Mydriatic (tropicamide and phenylephrine), 2228x1652, 50° FOV, retinal fundus photograph, posterior pole field covering the optic disc and macula, Topcon TRC-50DX — 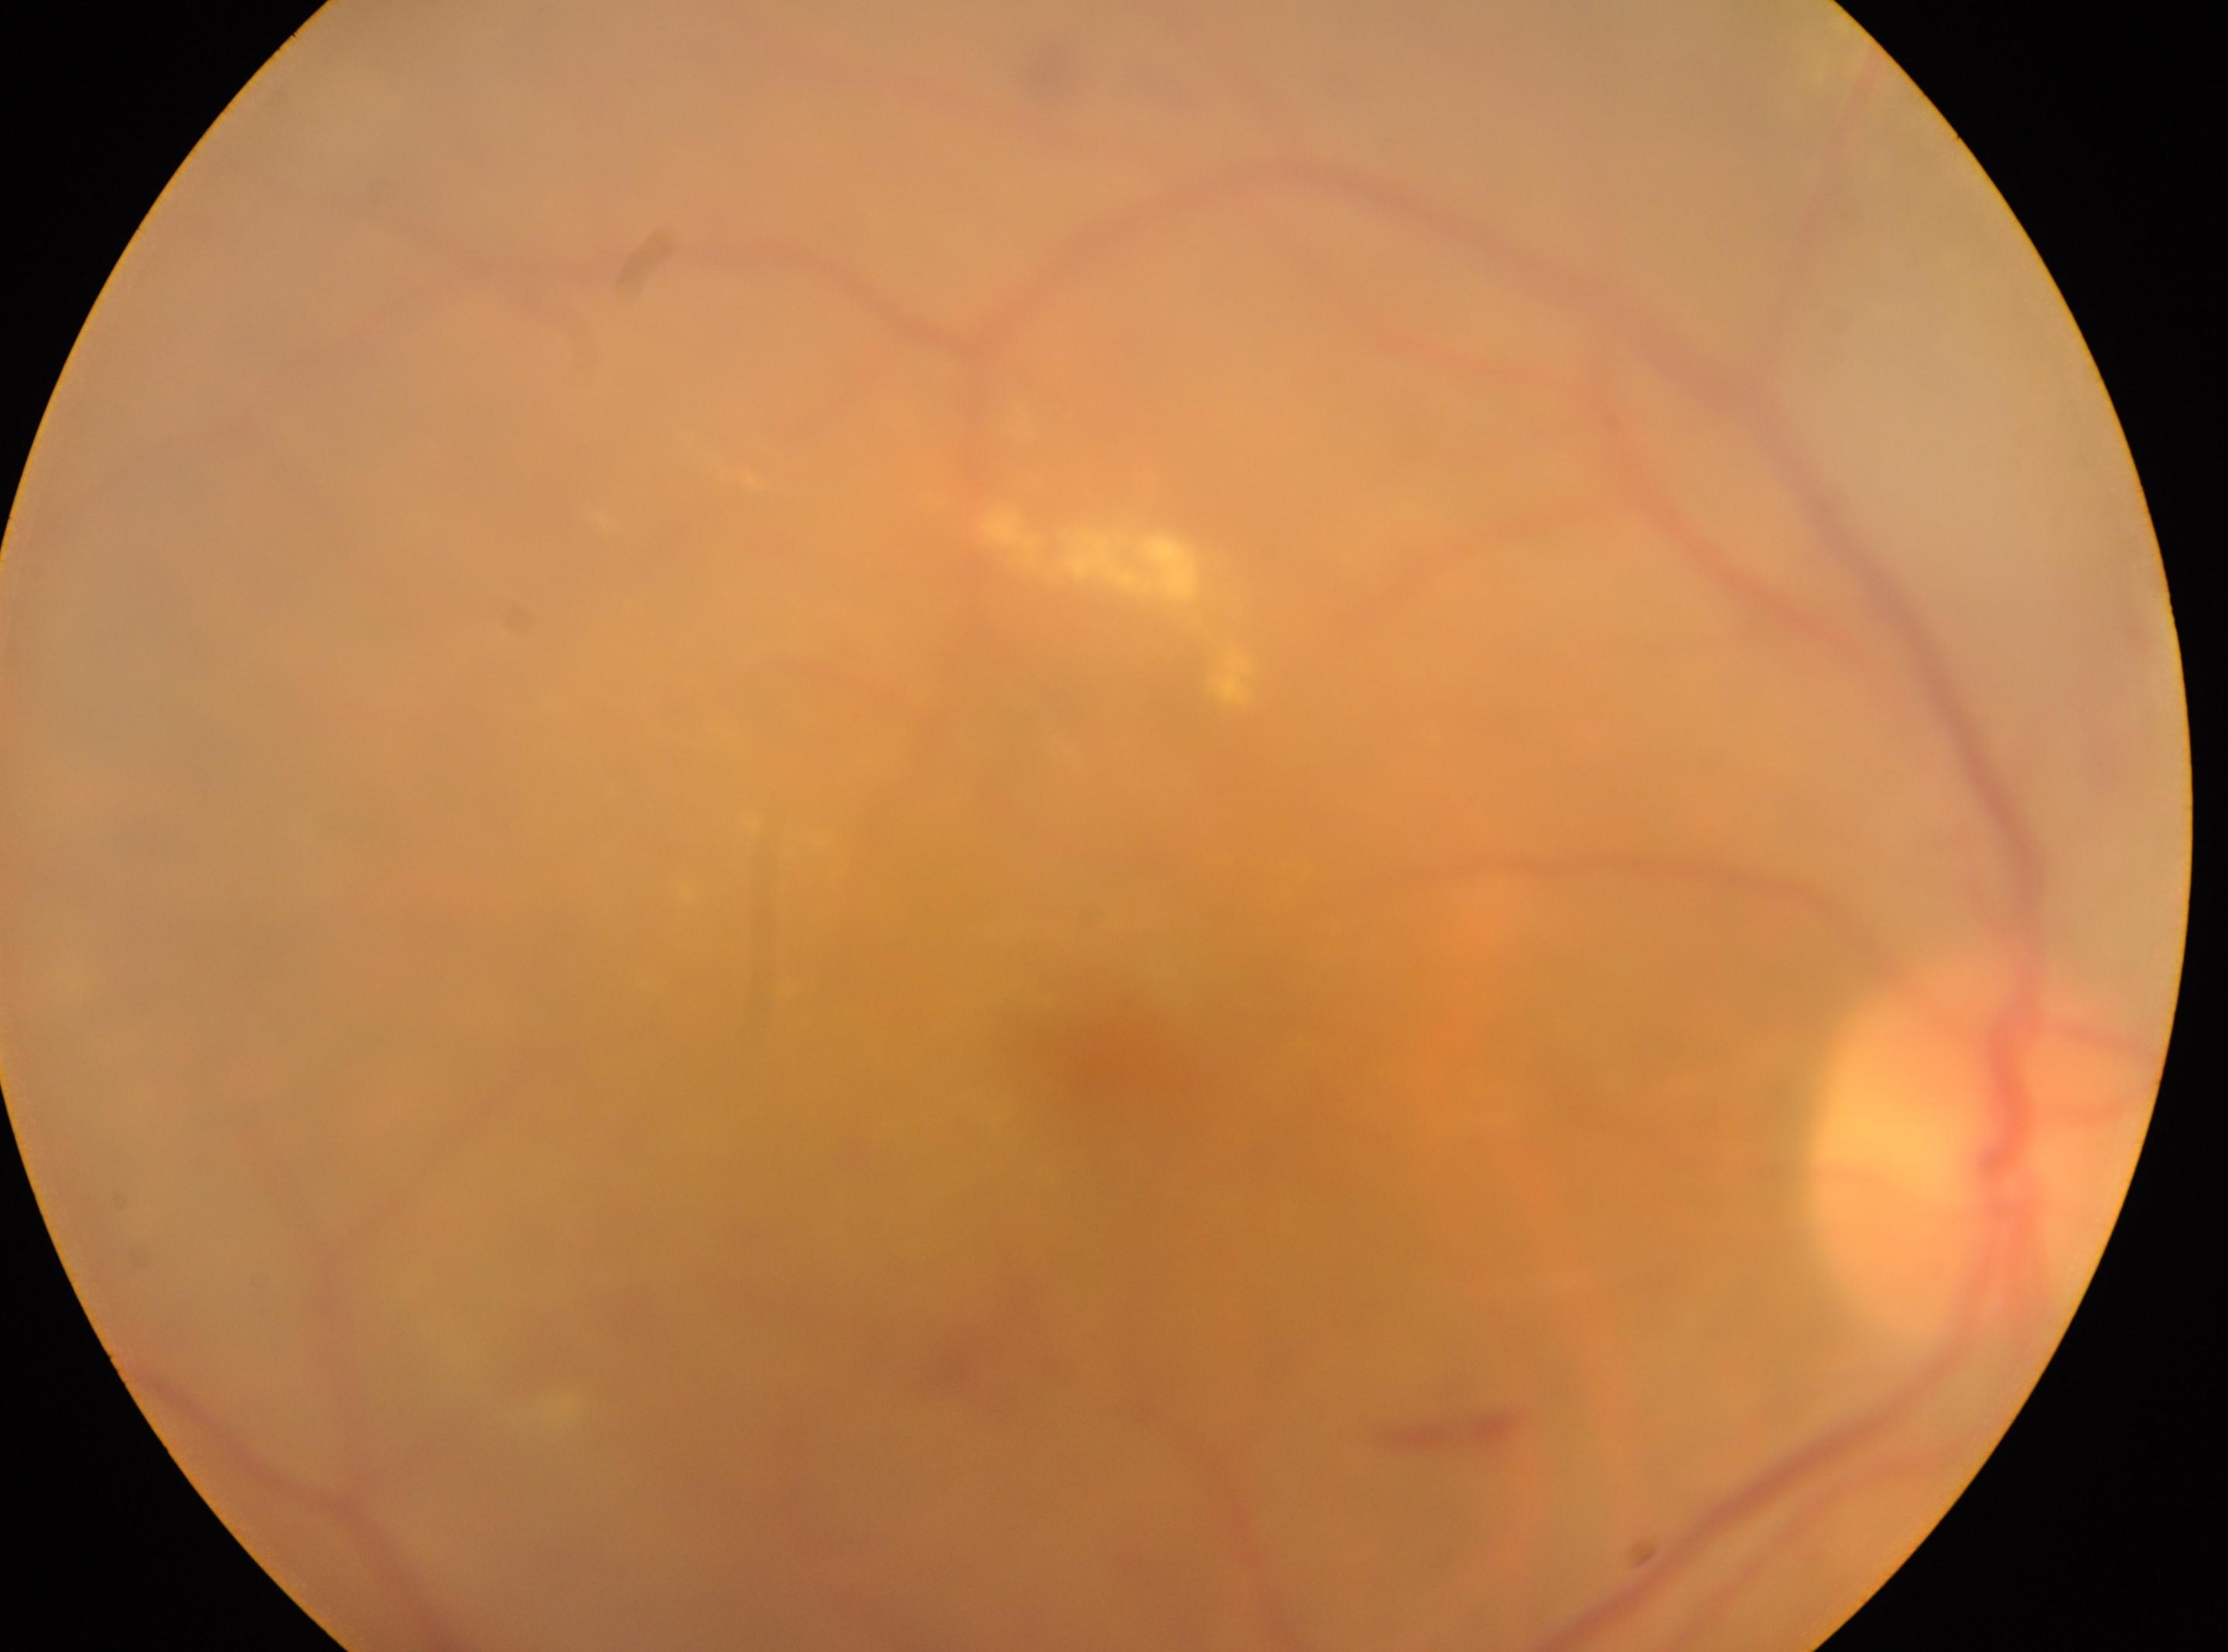 Annotations:
– optic disc: (1980,1145)
– laterality: the right eye
– diabetic retinopathy: moderate NPDR (grade 2) — more than just microaneurysms but less than severe NPDR
– foveal center: (1119,1067)